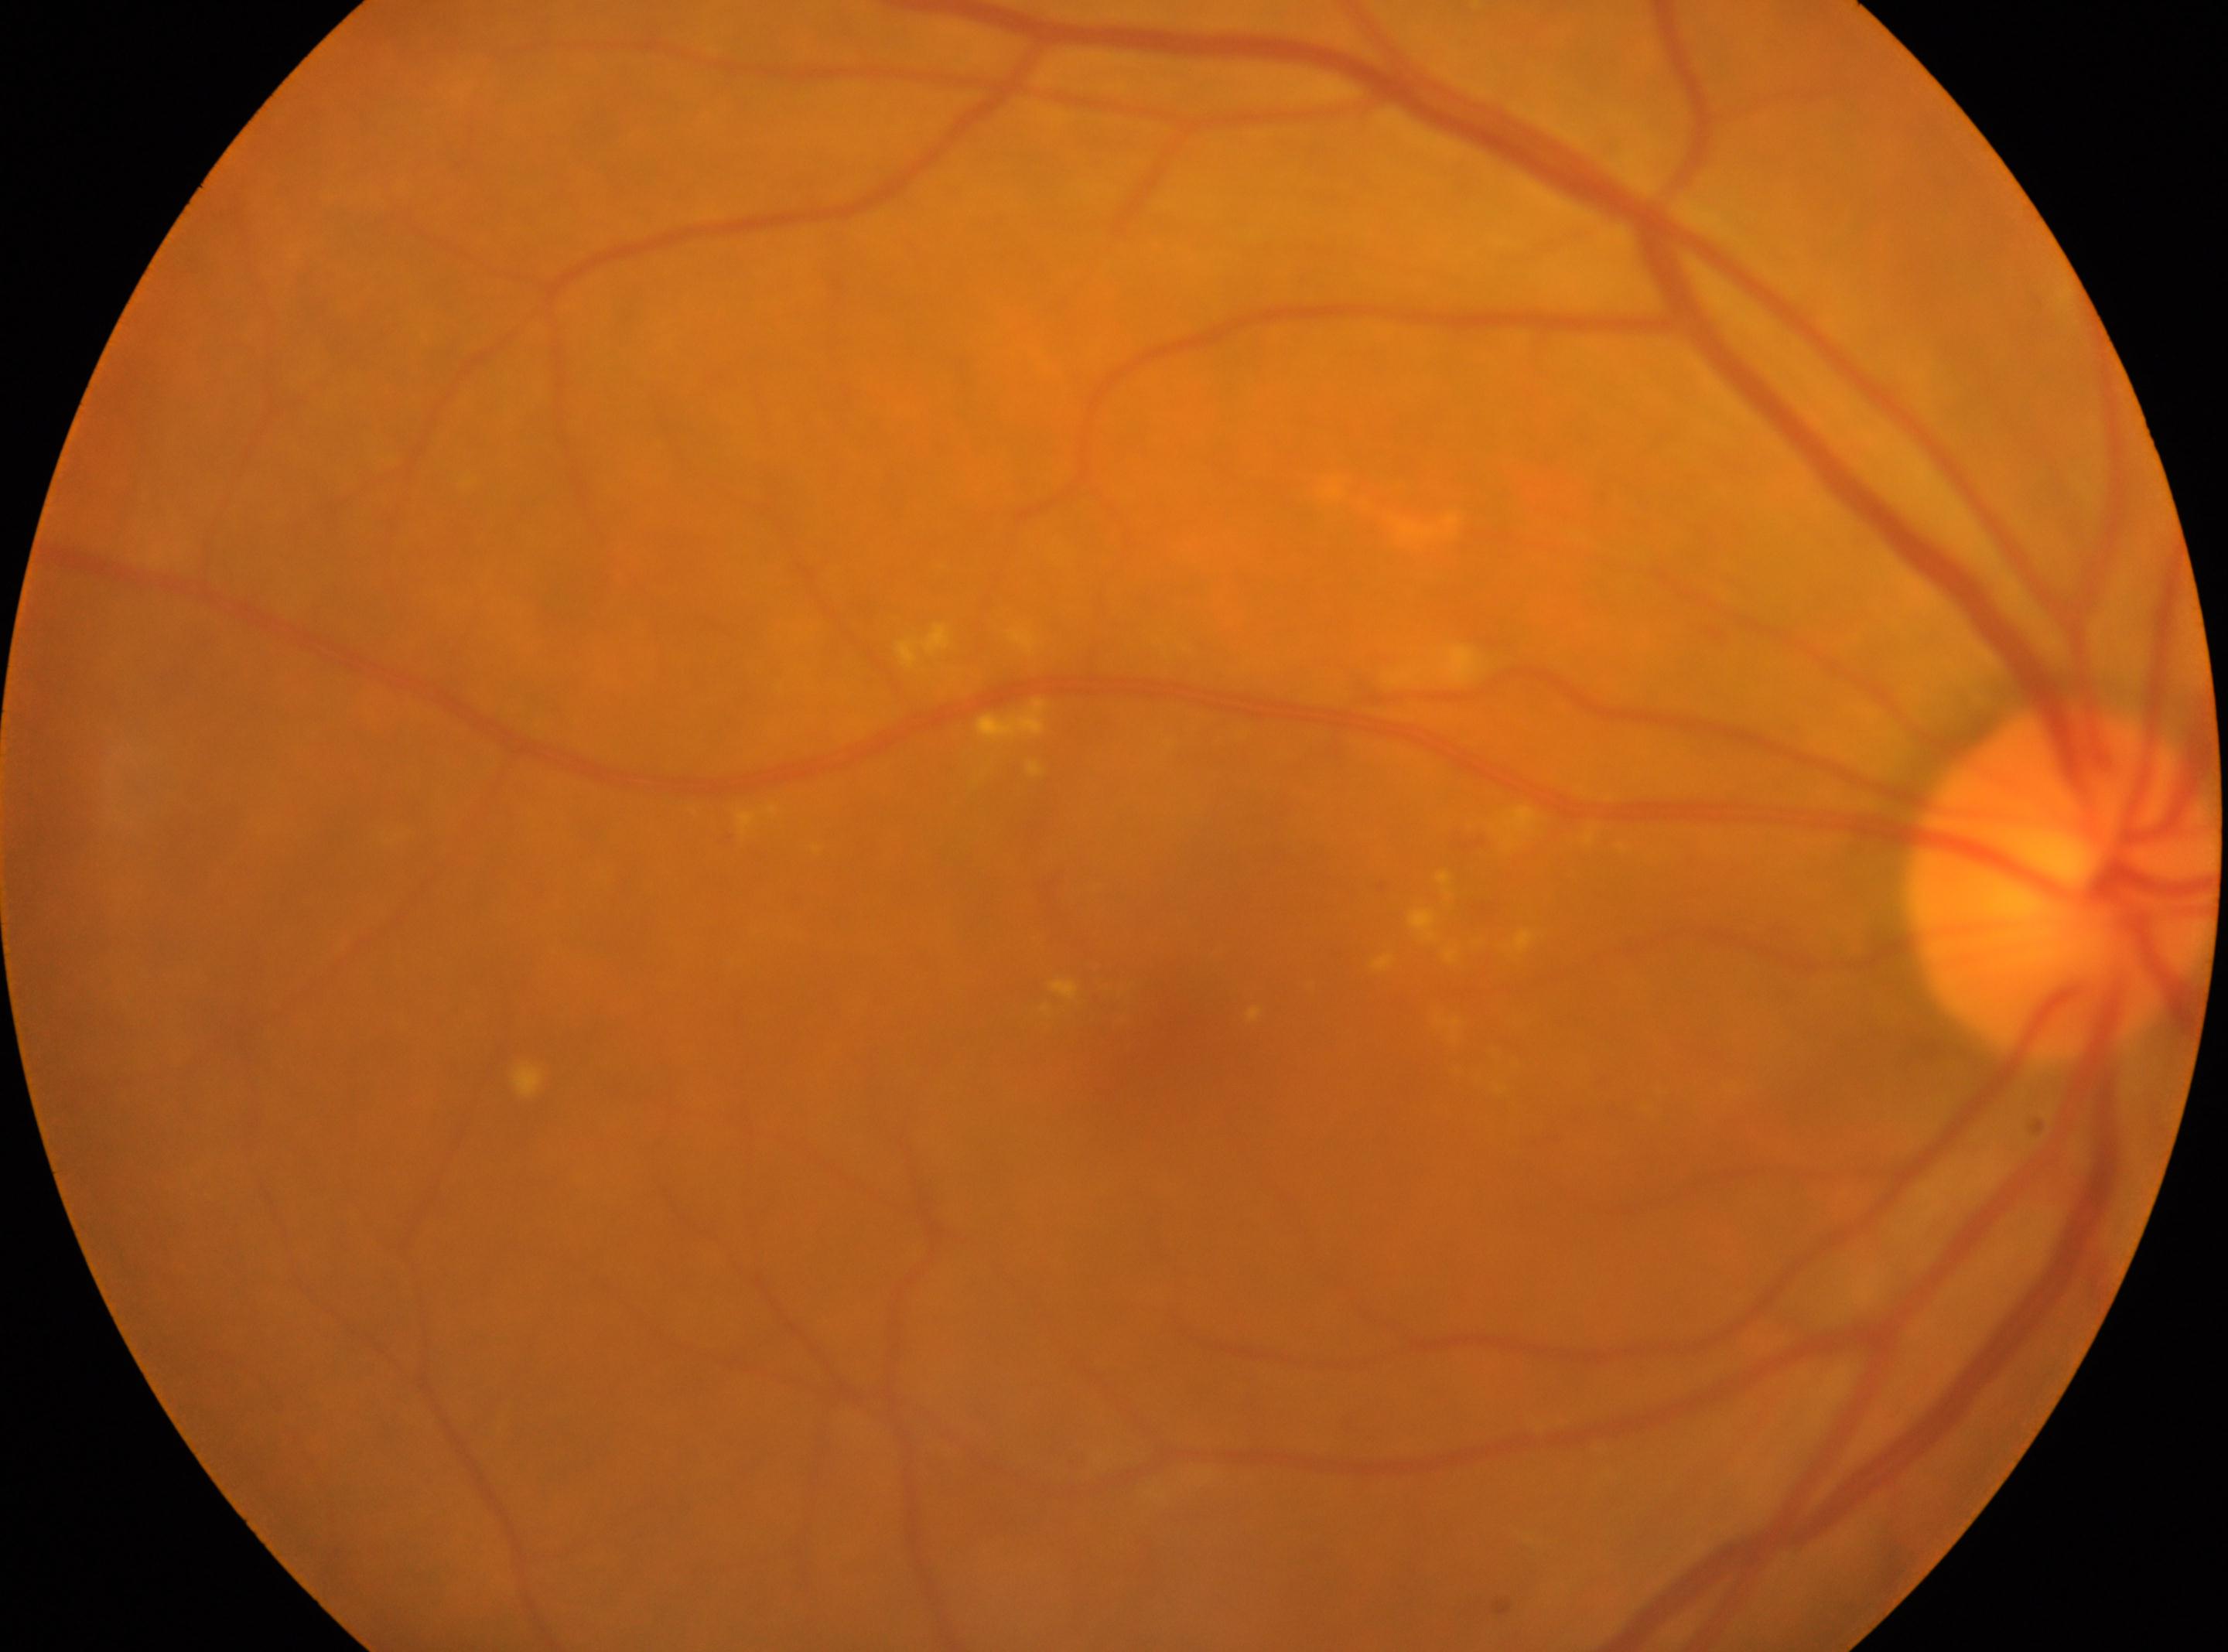 Annotations:
- diabetic retinopathy (DR) — moderate non-proliferative diabetic retinopathy (grade 2)
- fovea — x=1168, y=1021
- laterality — oculus dexter
- DR class — non-proliferative diabetic retinopathy
- optic disc center — x=2061, y=880